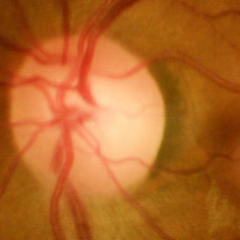

Optic disc photograph demonstrating no signs of glaucoma.